Image size 2352x1568 — 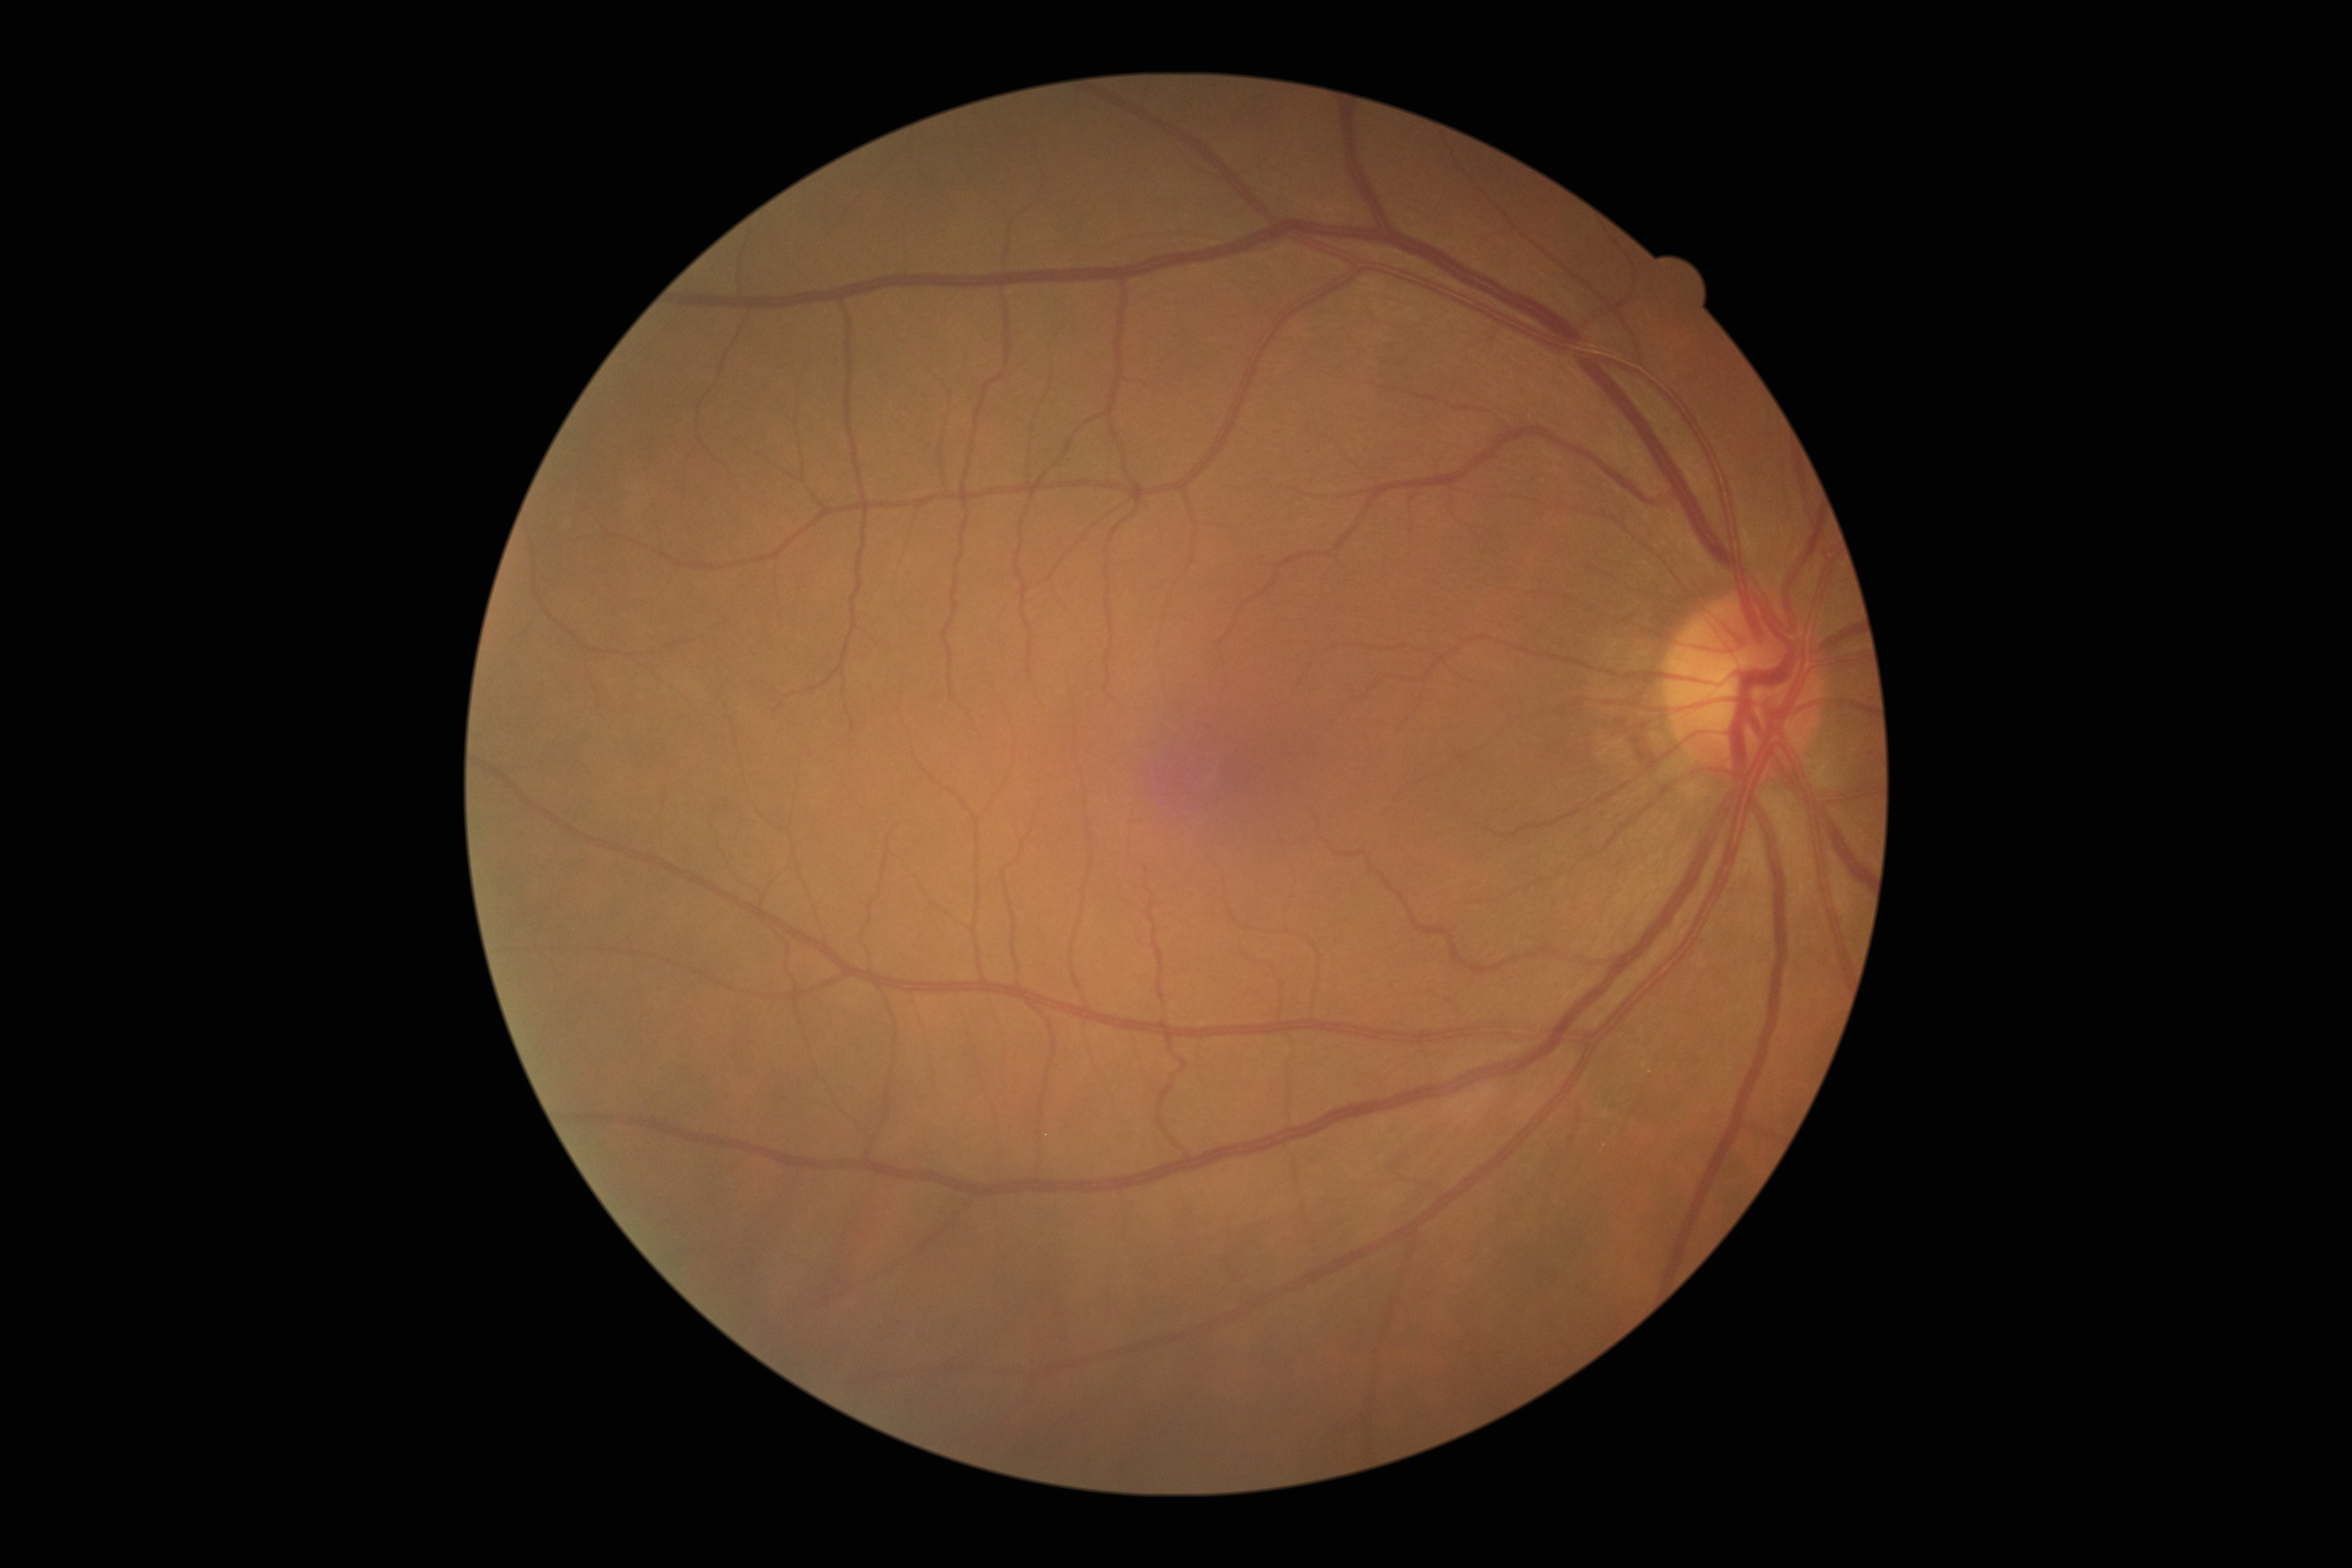
Retinopathy grade: 0.
No signs of diabetic retinopathy.